2102x1736px.
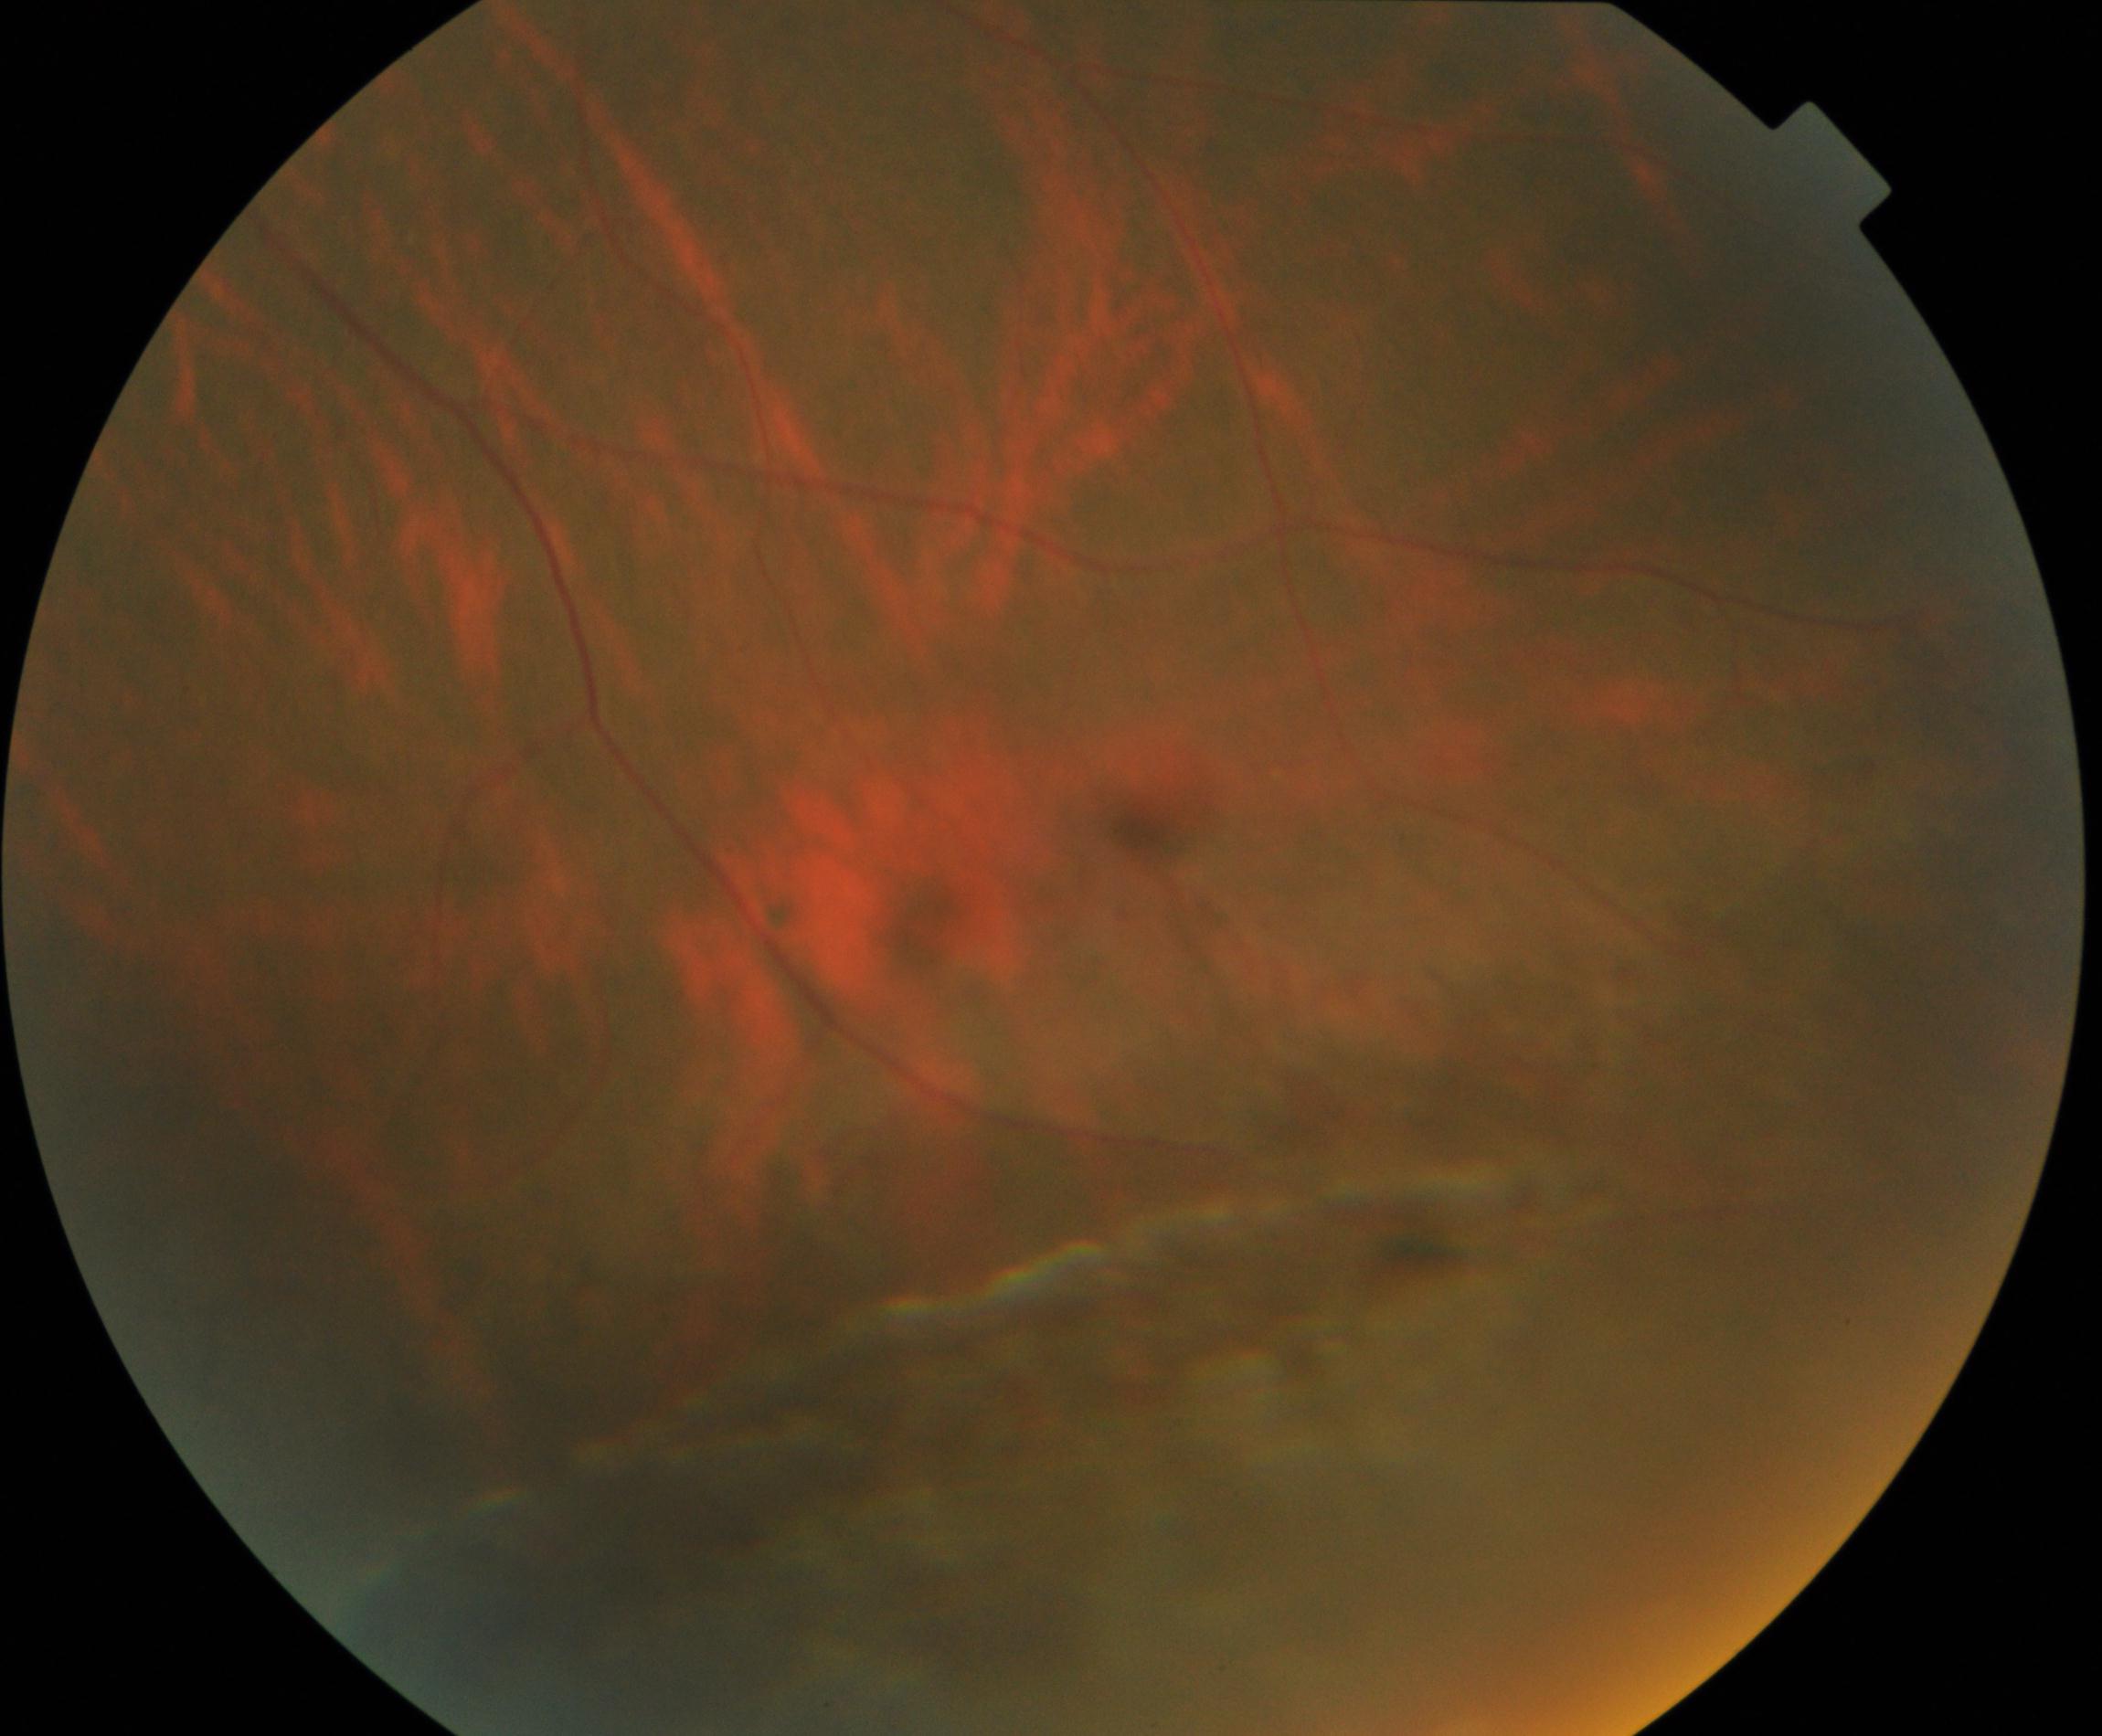

Findings: peripheral retinal degeneration and break.